Image size 848x848 — 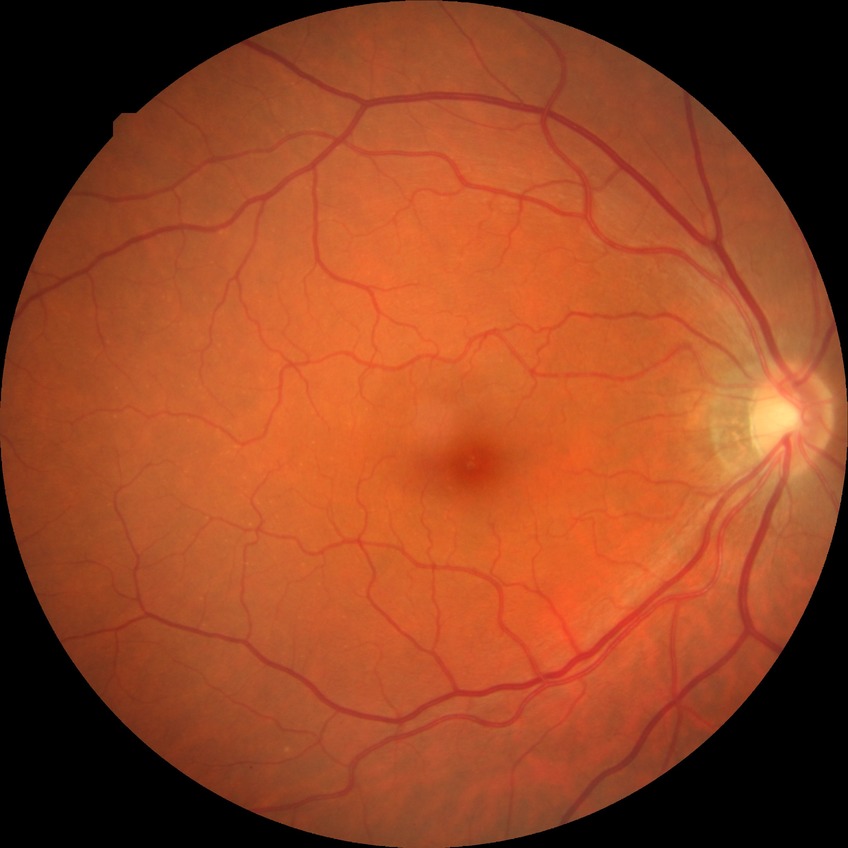
Diabetic retinopathy severity: no diabetic retinopathy.